Color fundus photograph · 2048 x 1536 pixels:
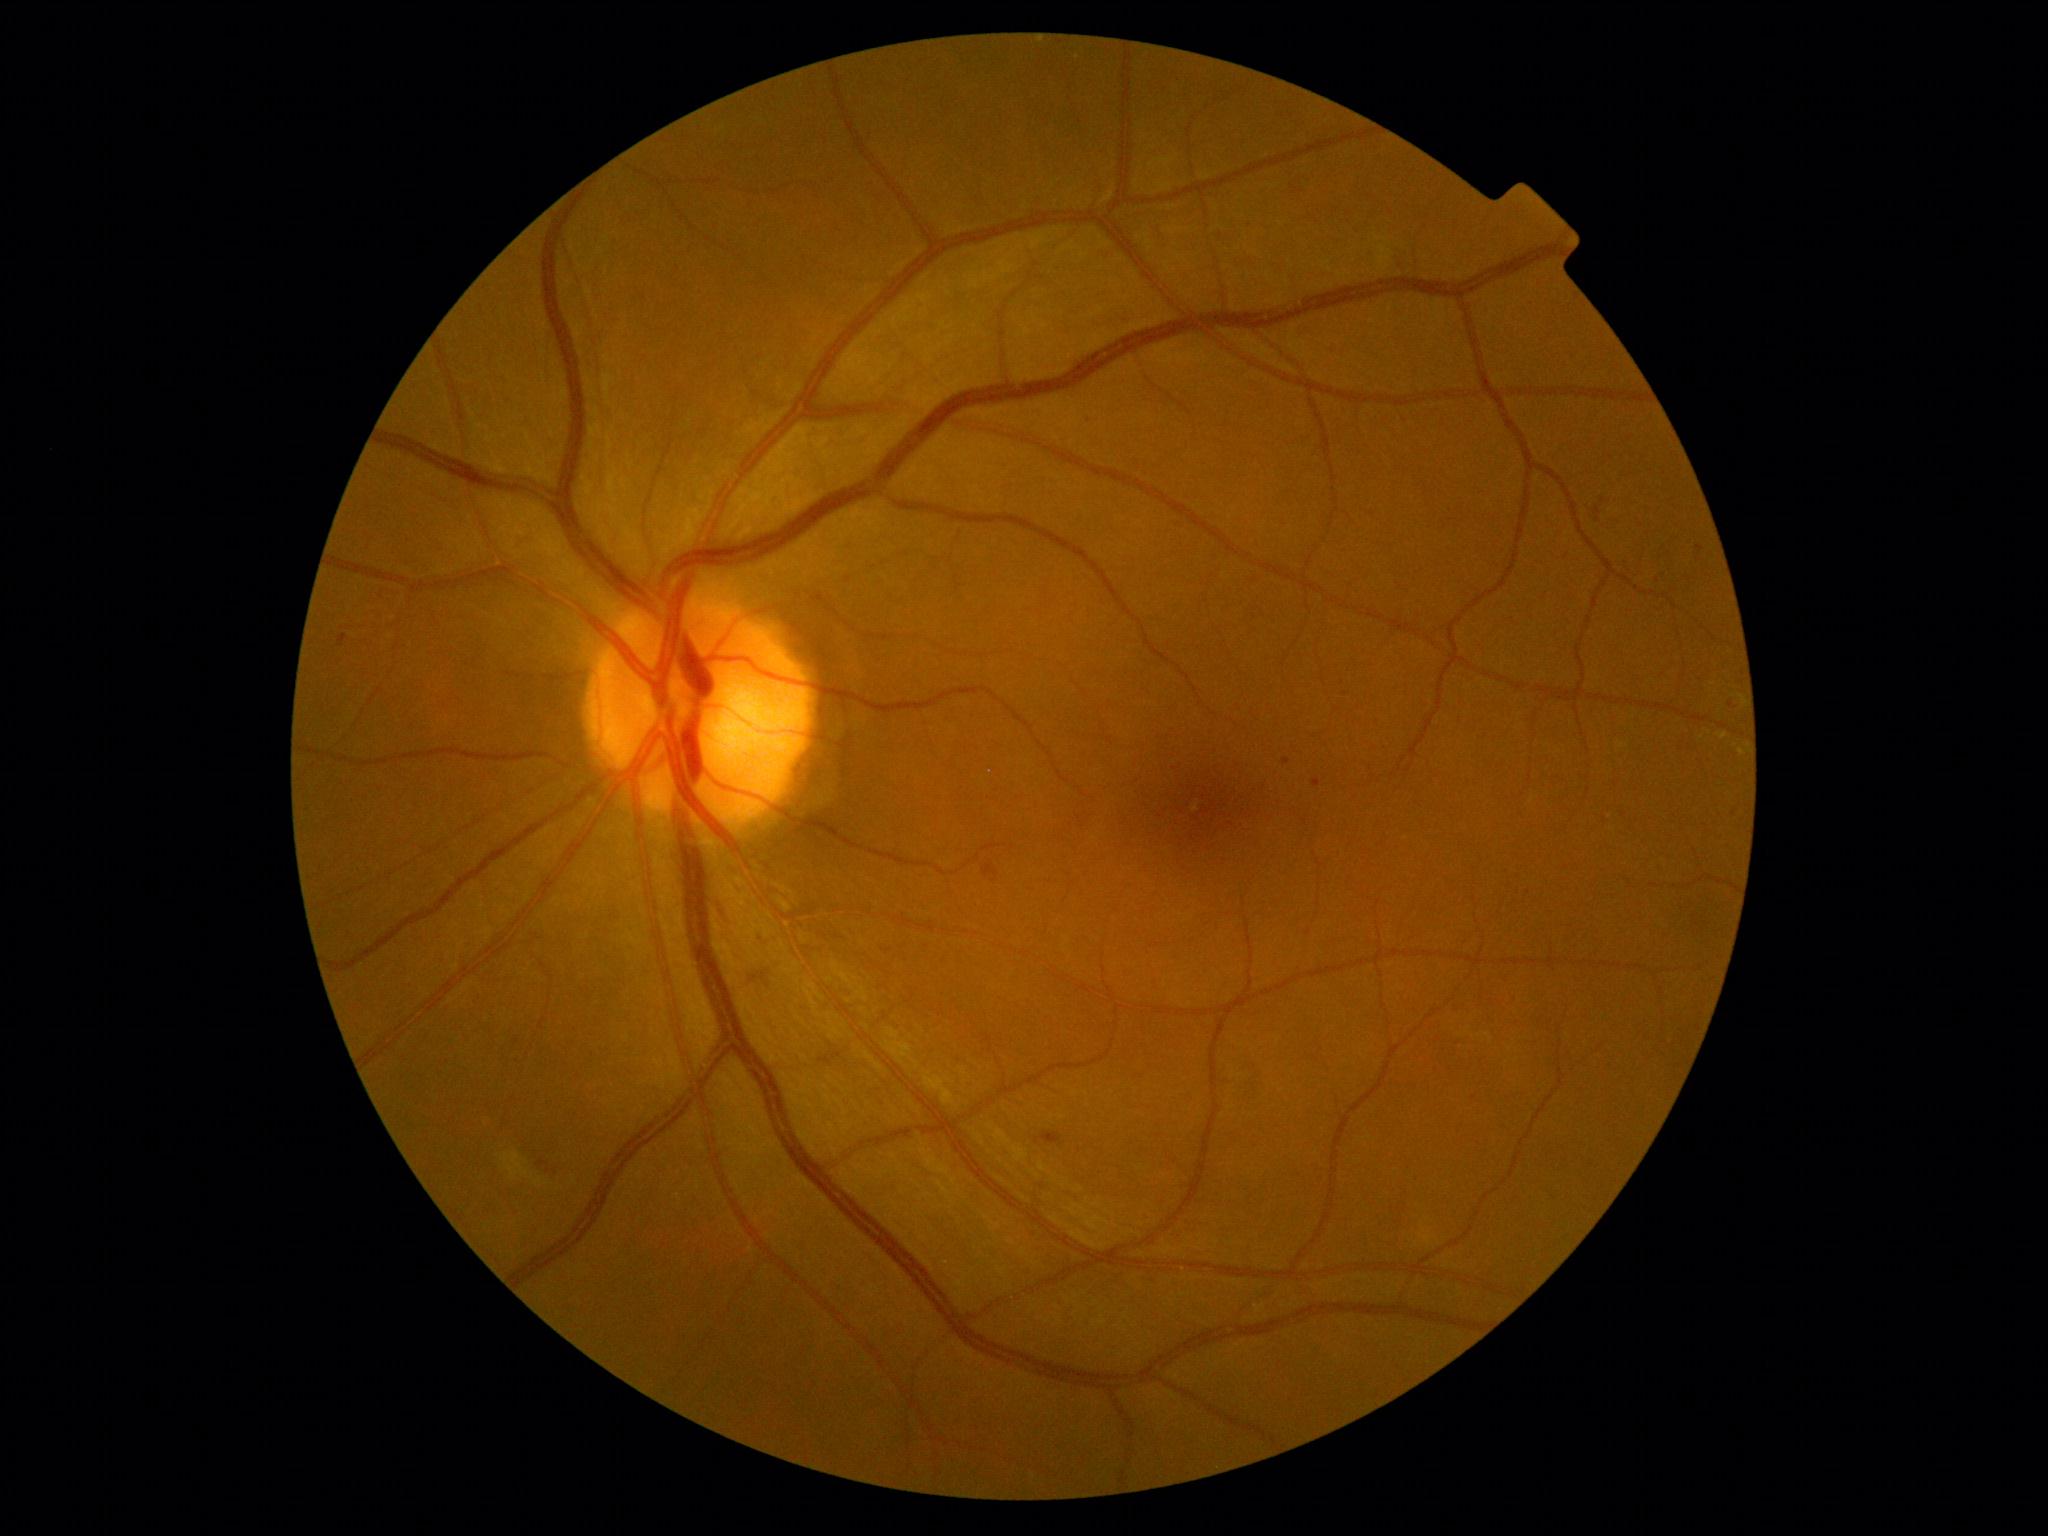
Retinopathy: moderate non-proliferative diabetic retinopathy (grade 2).